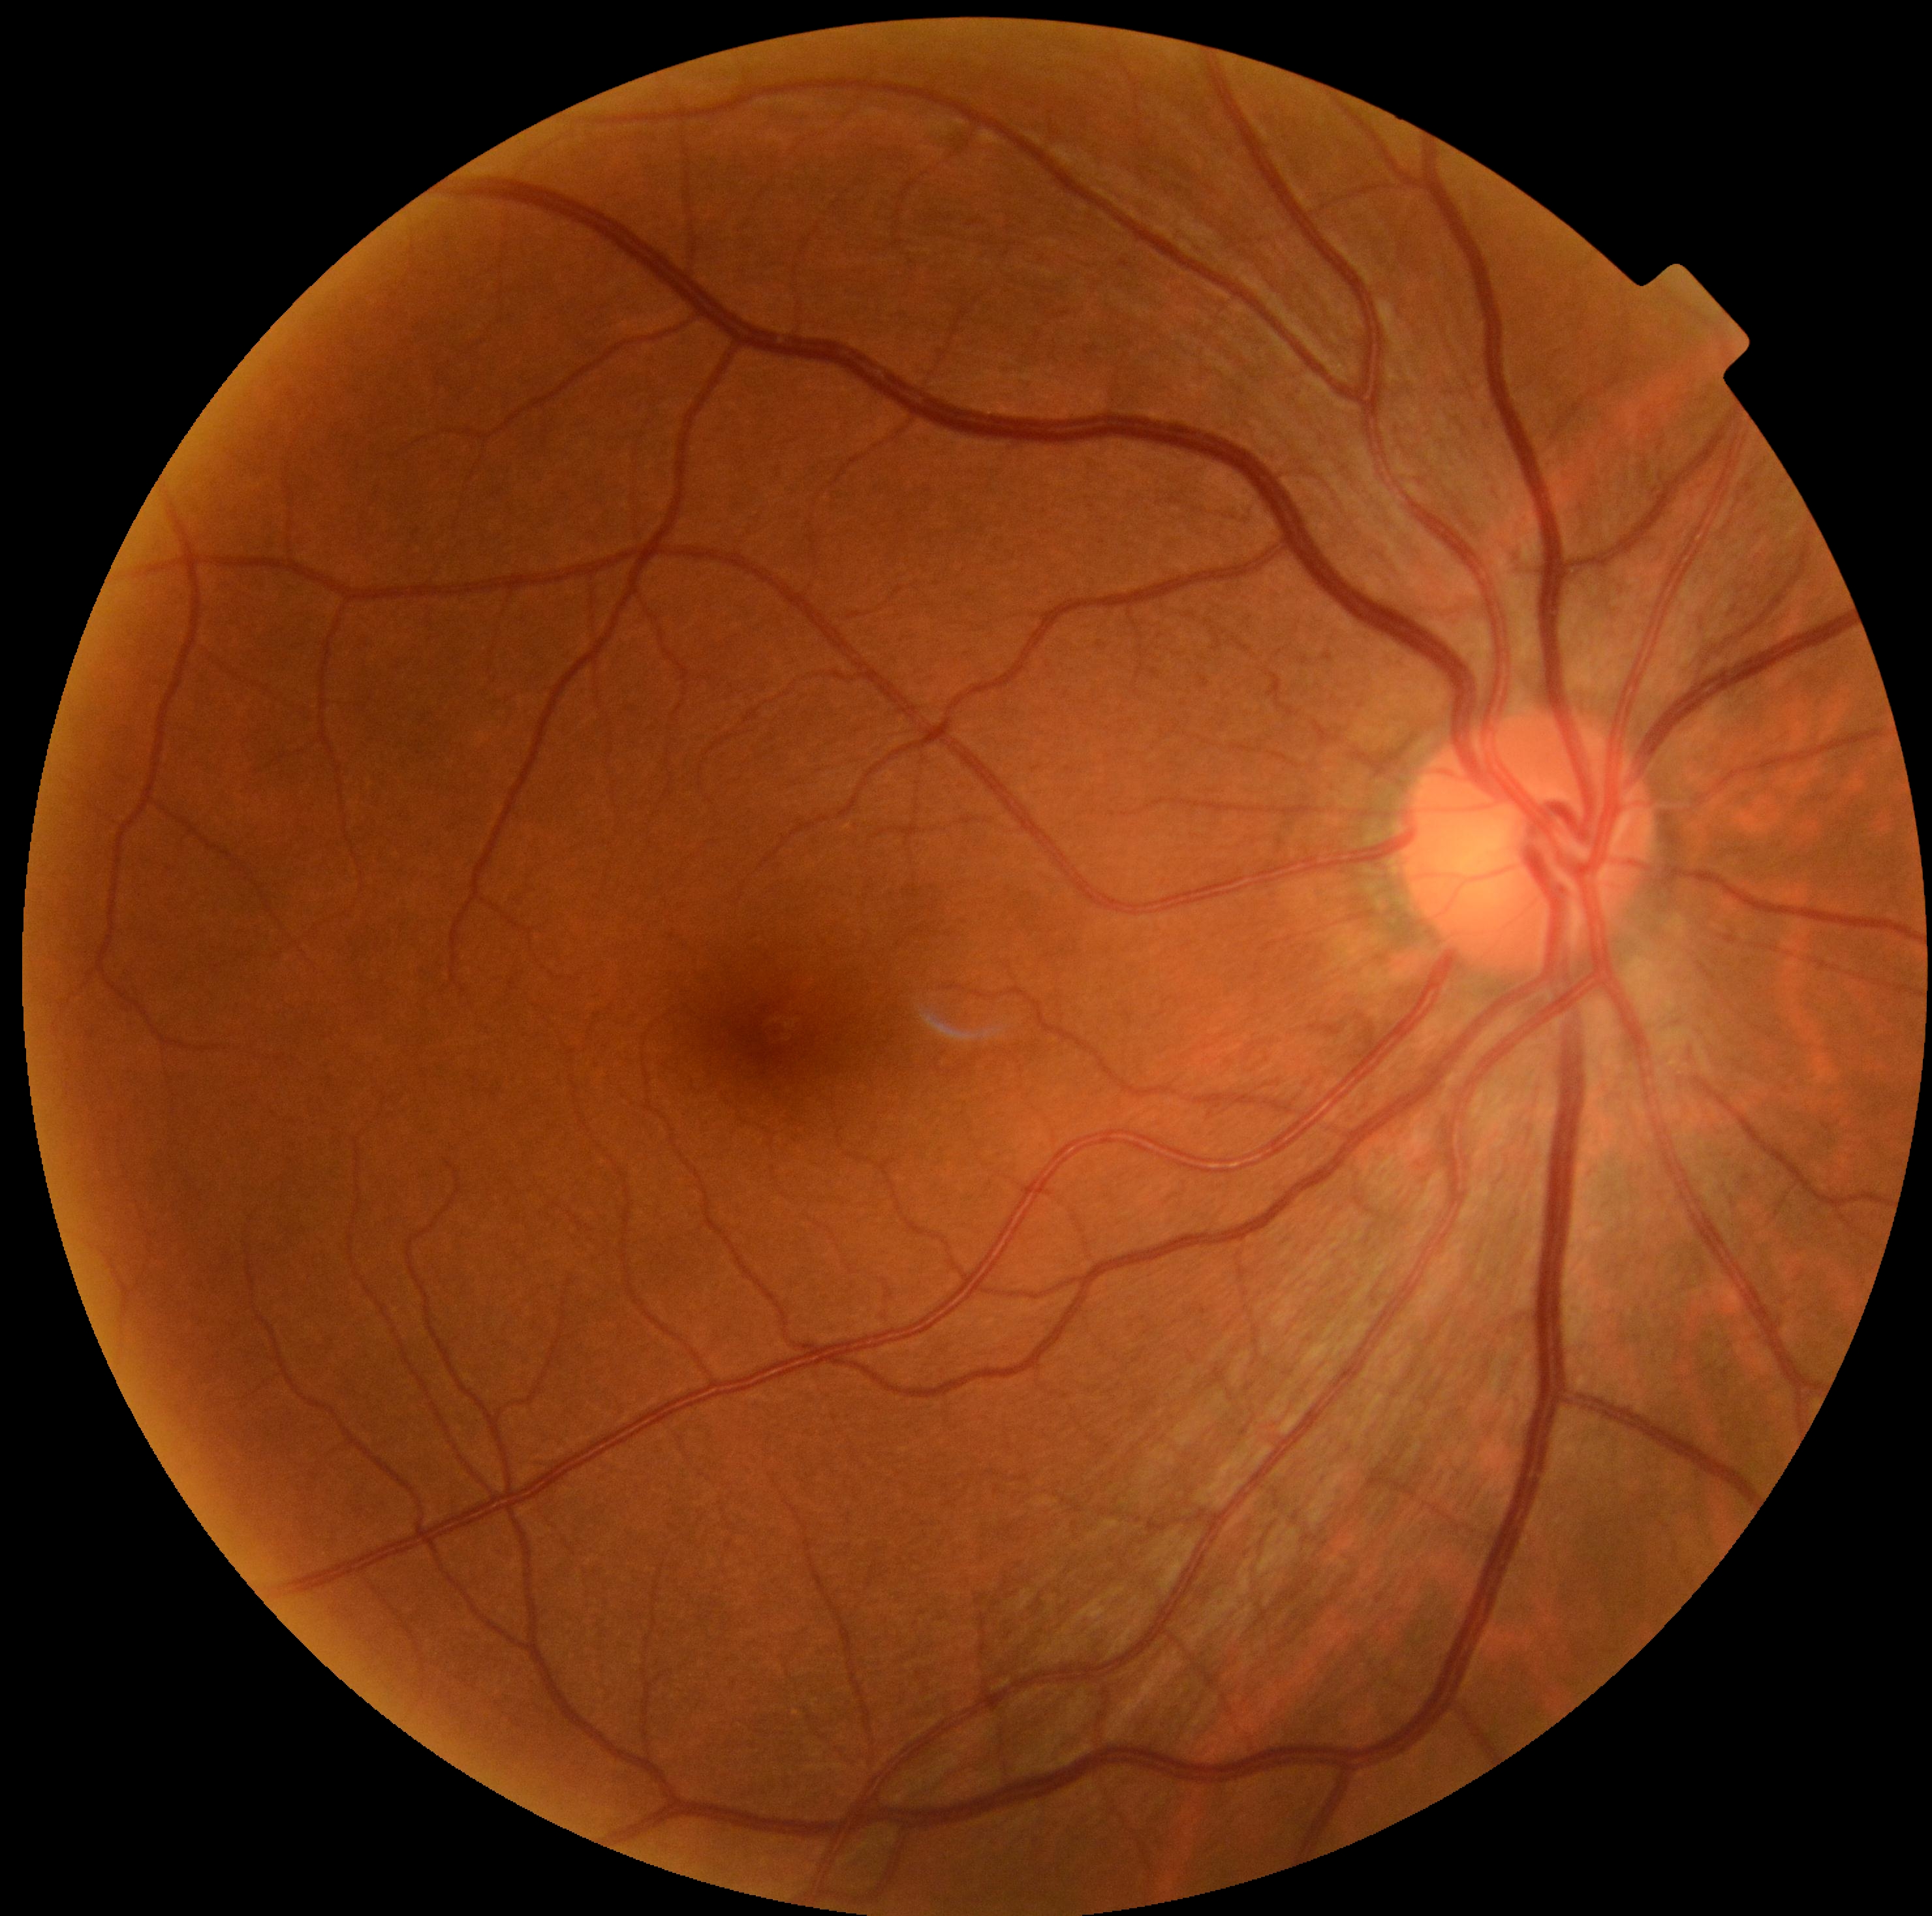

DR severity is no apparent diabetic retinopathy (grade 0).